Posterior pole photograph; 848x848; acquired with a NIDEK AFC-230; Davis DR grading; 45° field of view.
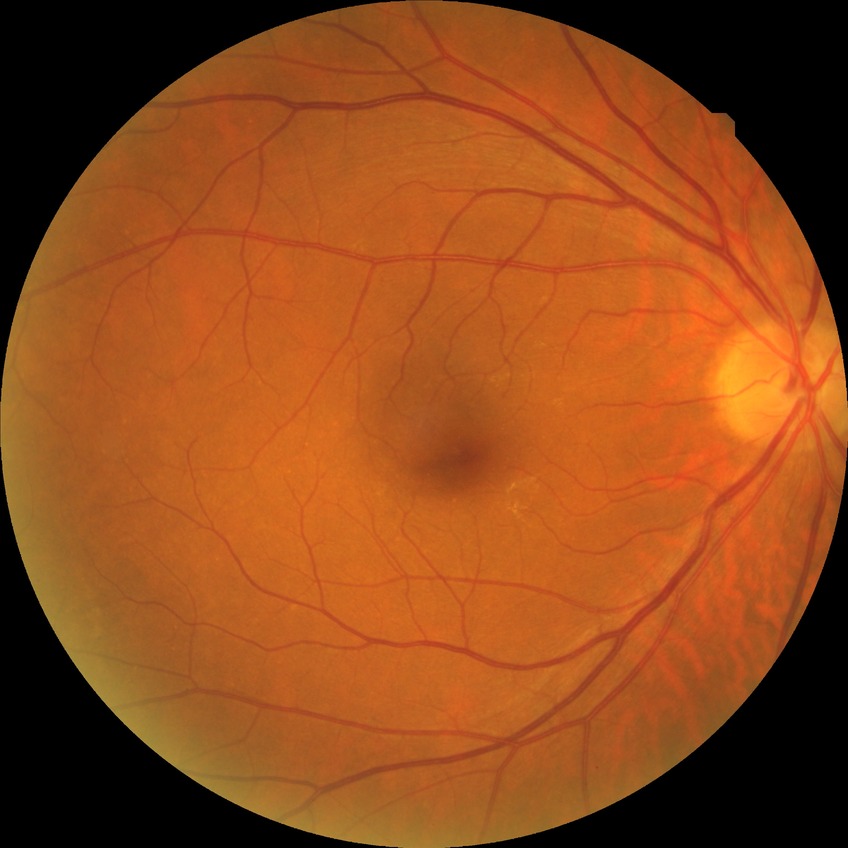 Annotations:
- retinopathy stage — no diabetic retinopathy